848x848.
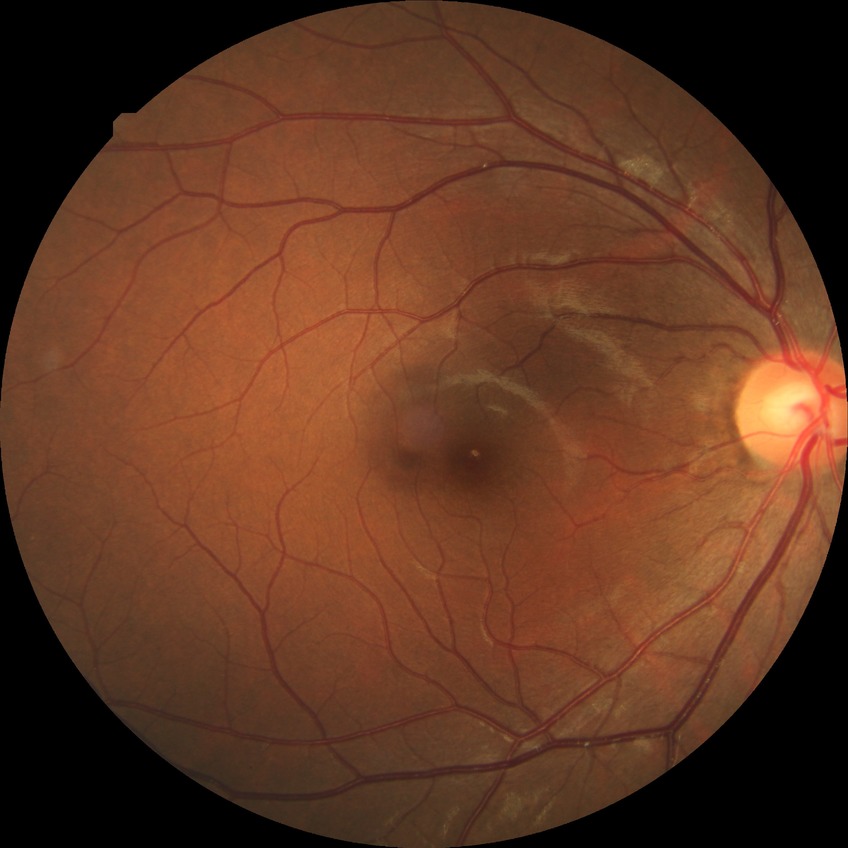 Retinopathy stage: no diabetic retinopathy.